Retinal fundus photograph: 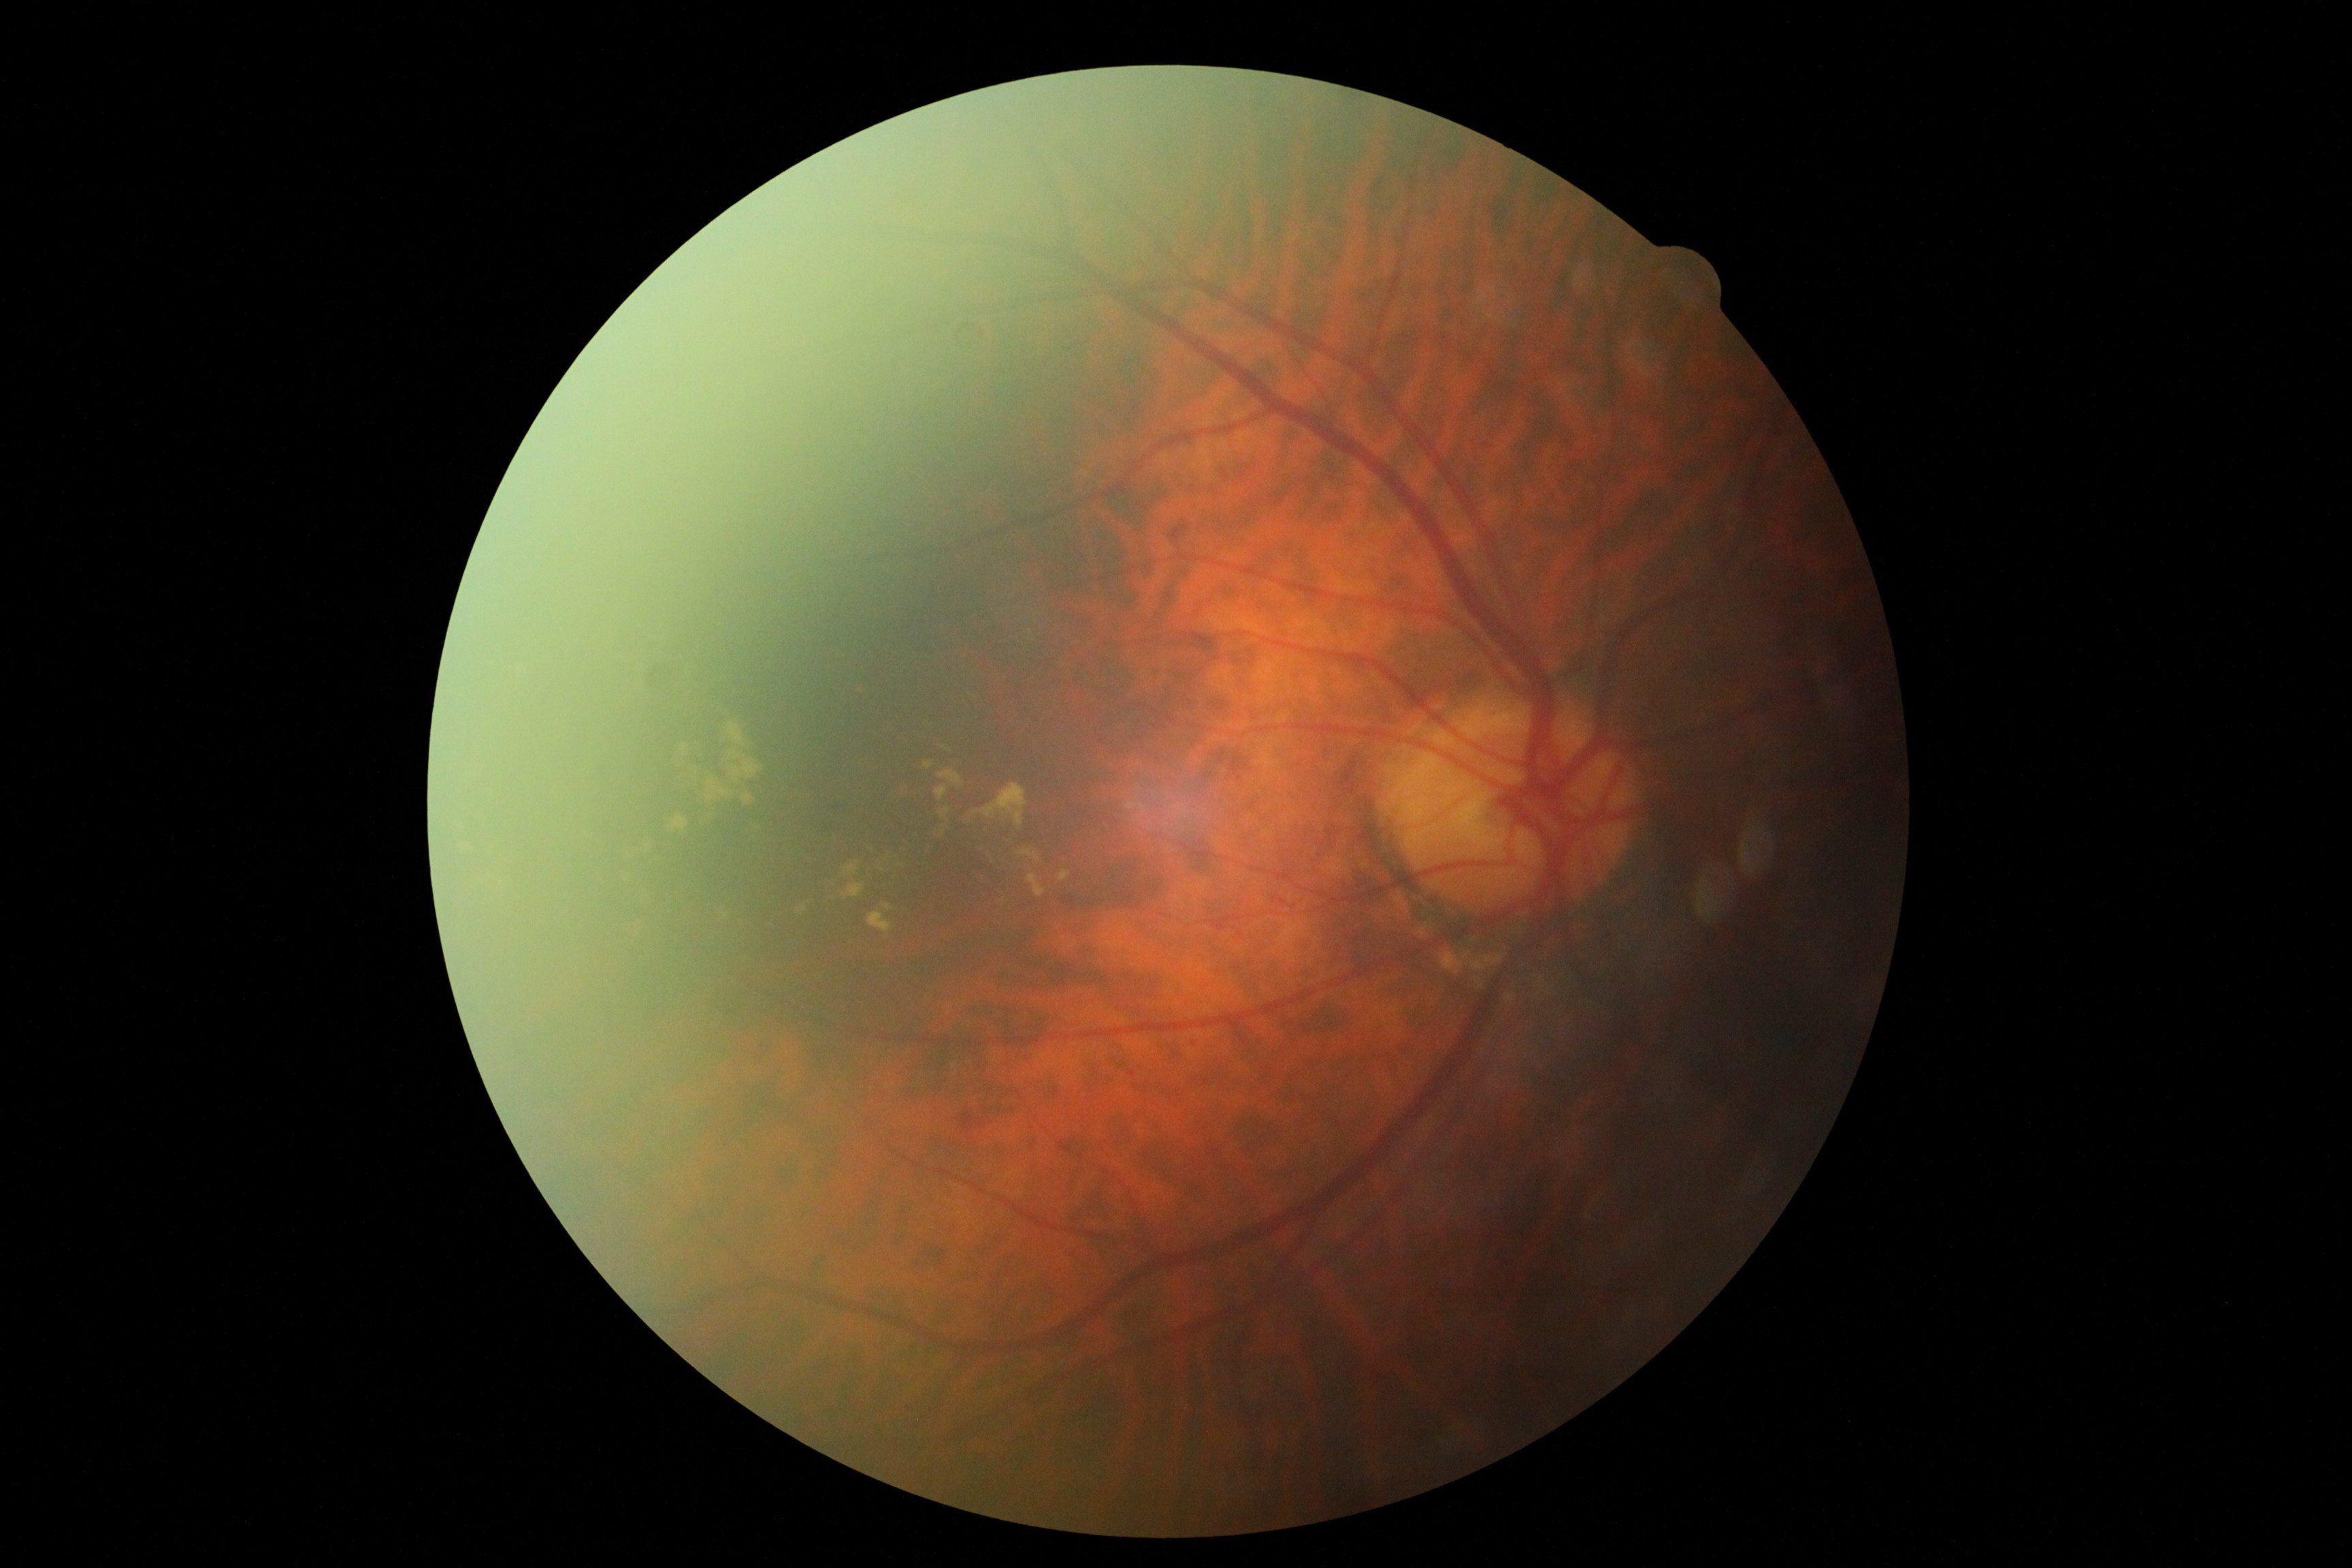
DR severity is grade 2.